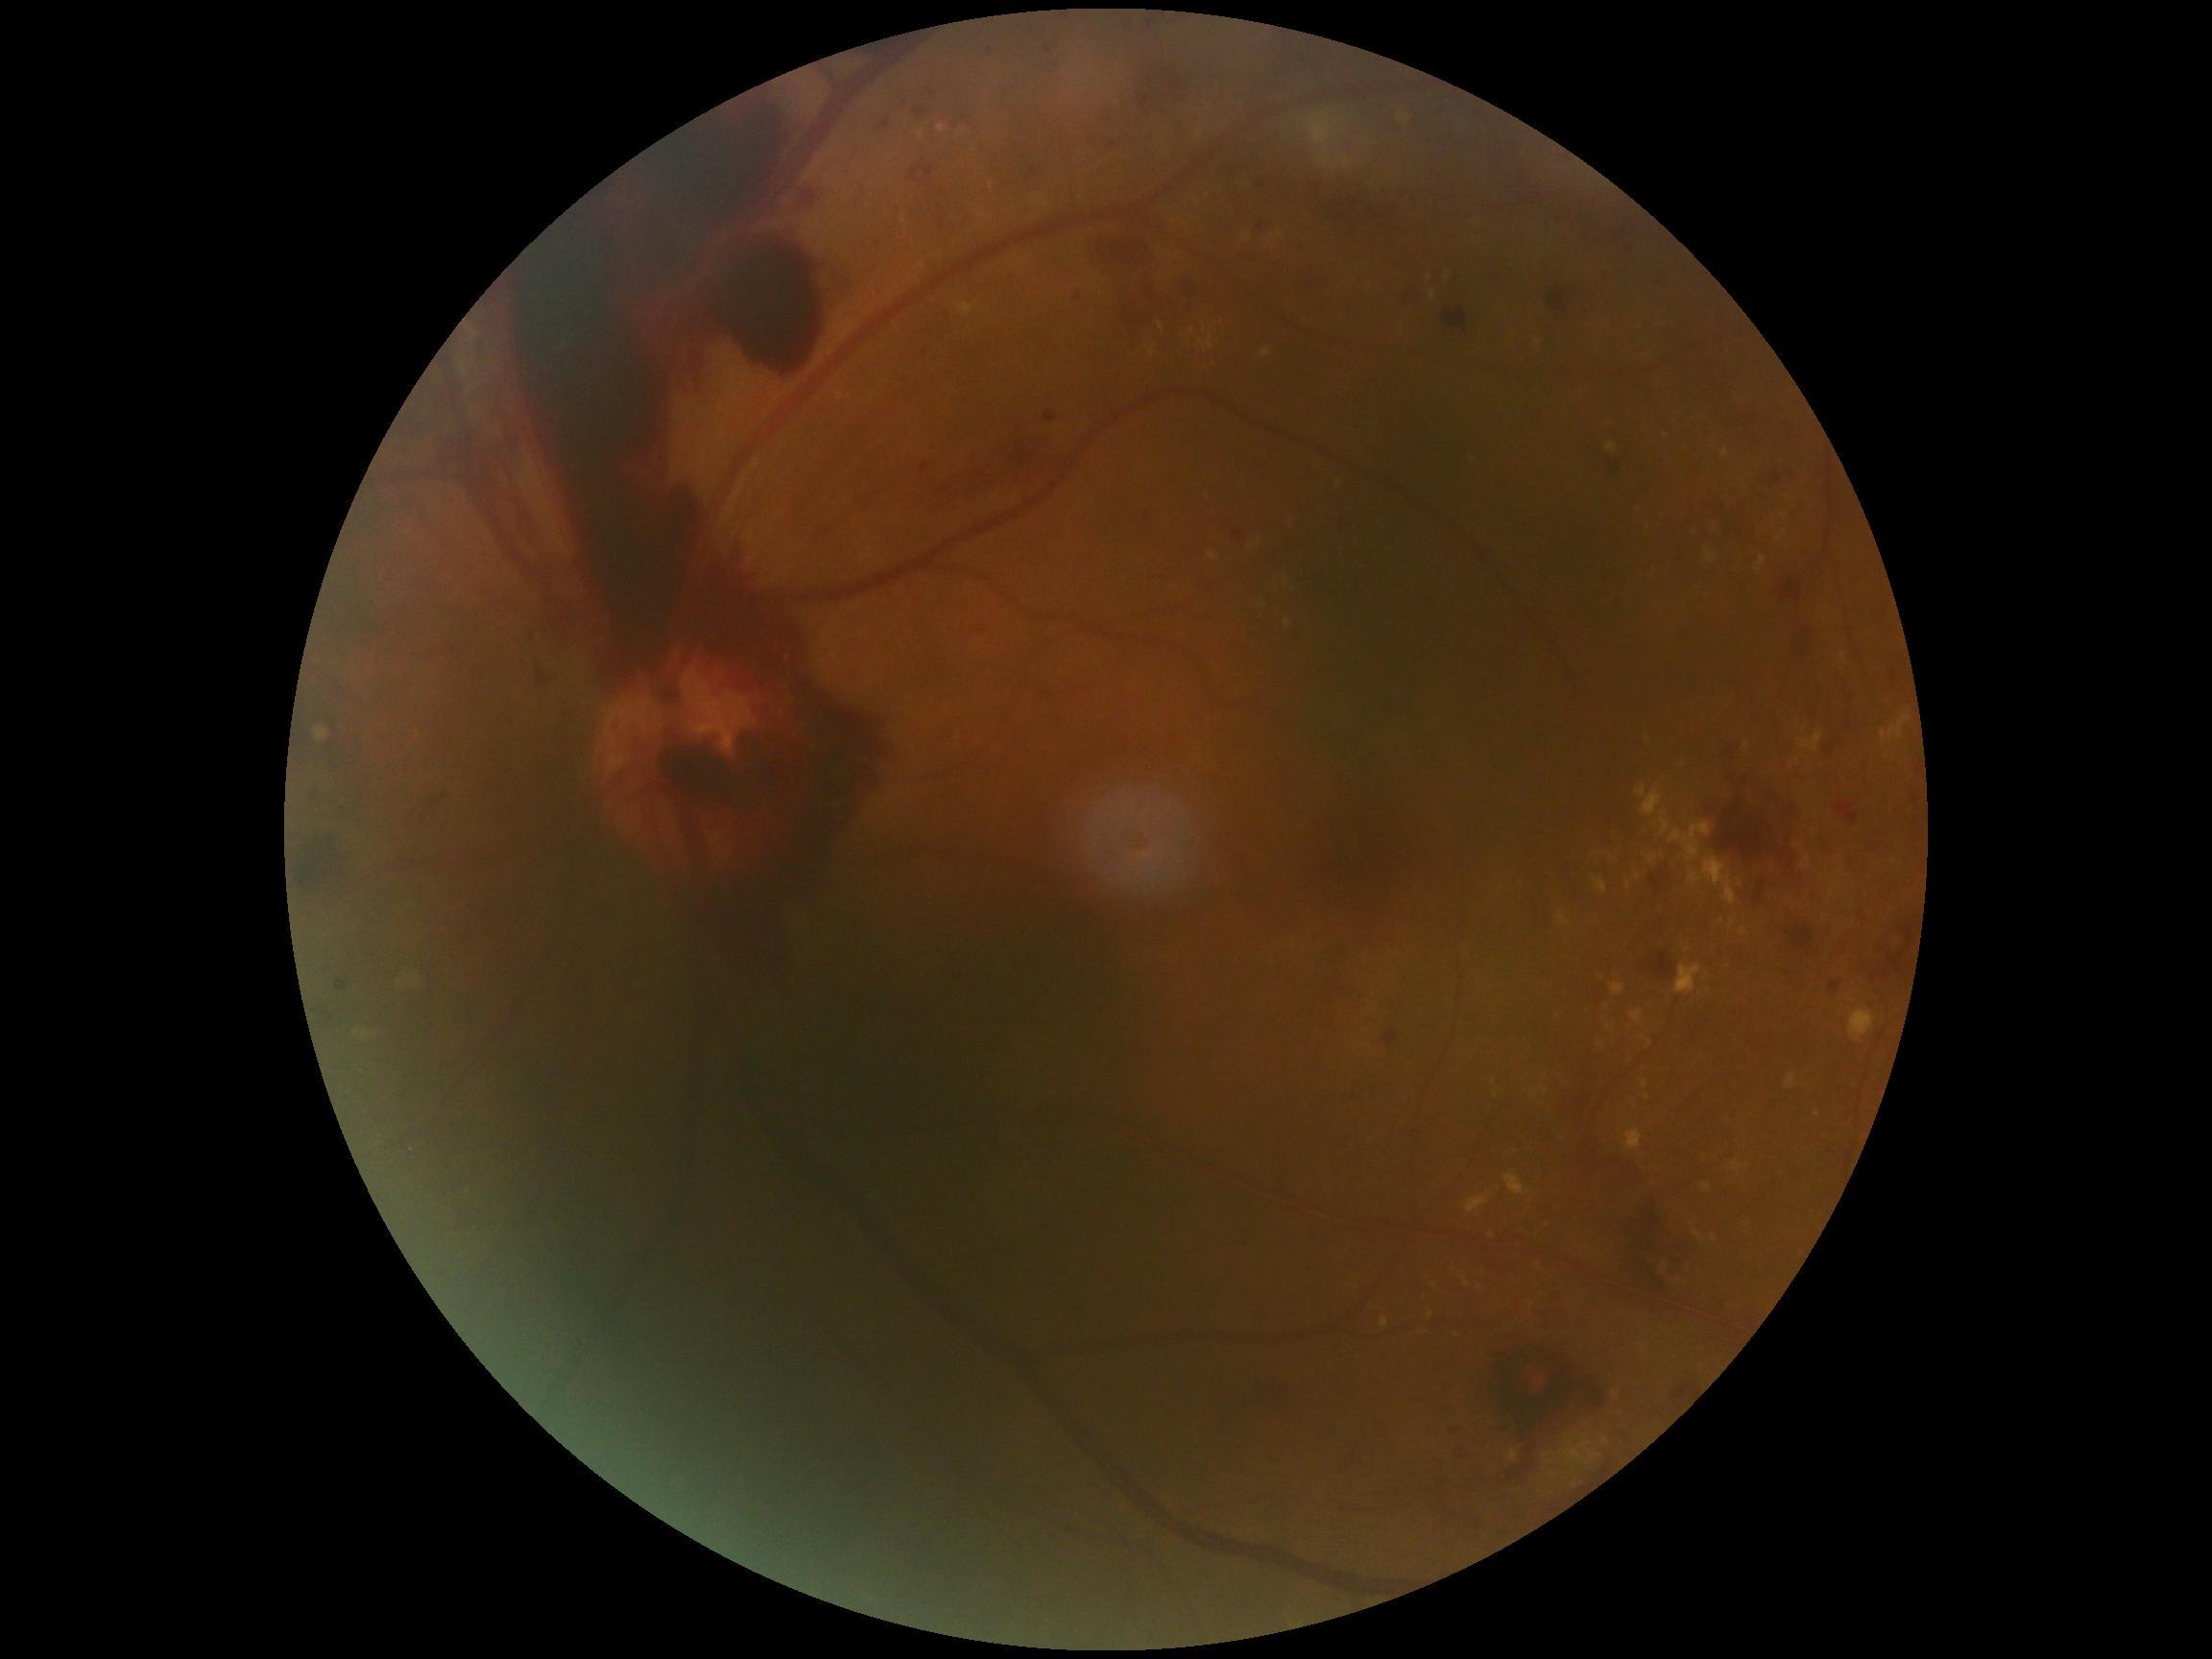
DR grade: proliferative diabetic retinopathy (4).